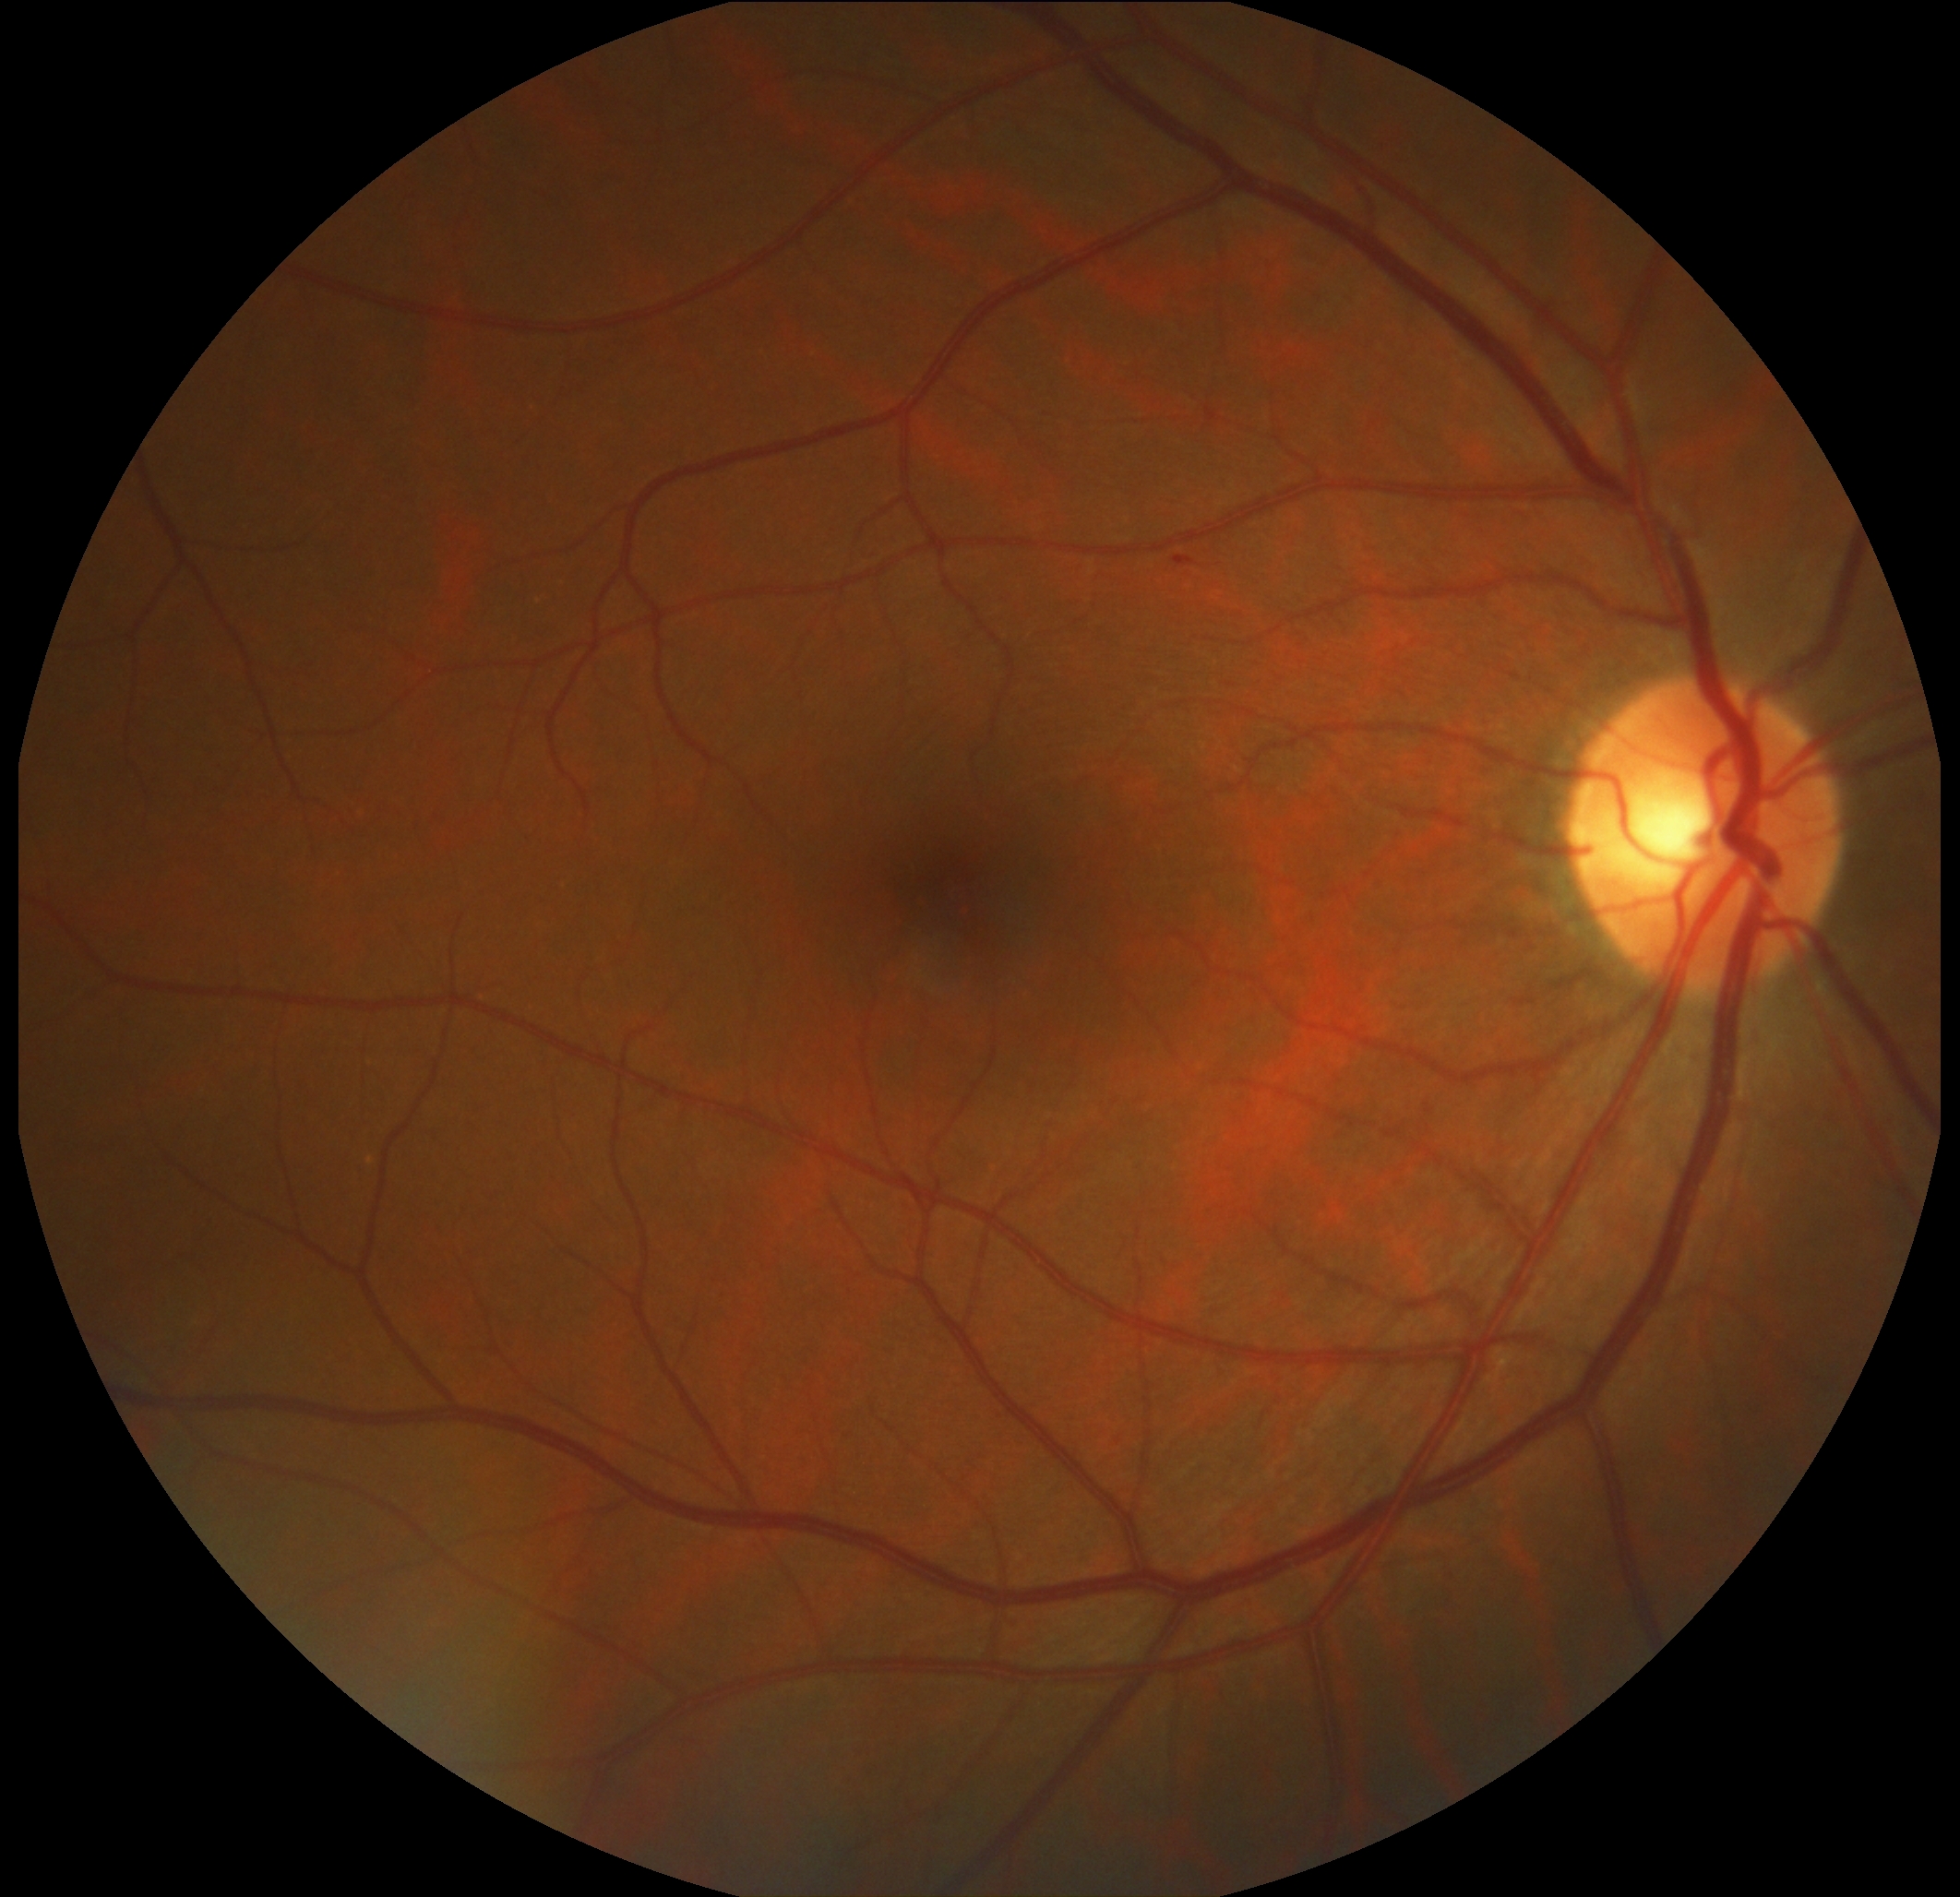

DR severity: moderate non-proliferative diabetic retinopathy (grade 2). The retinopathy is classified as non-proliferative diabetic retinopathy.